1932 x 1932 pixels — 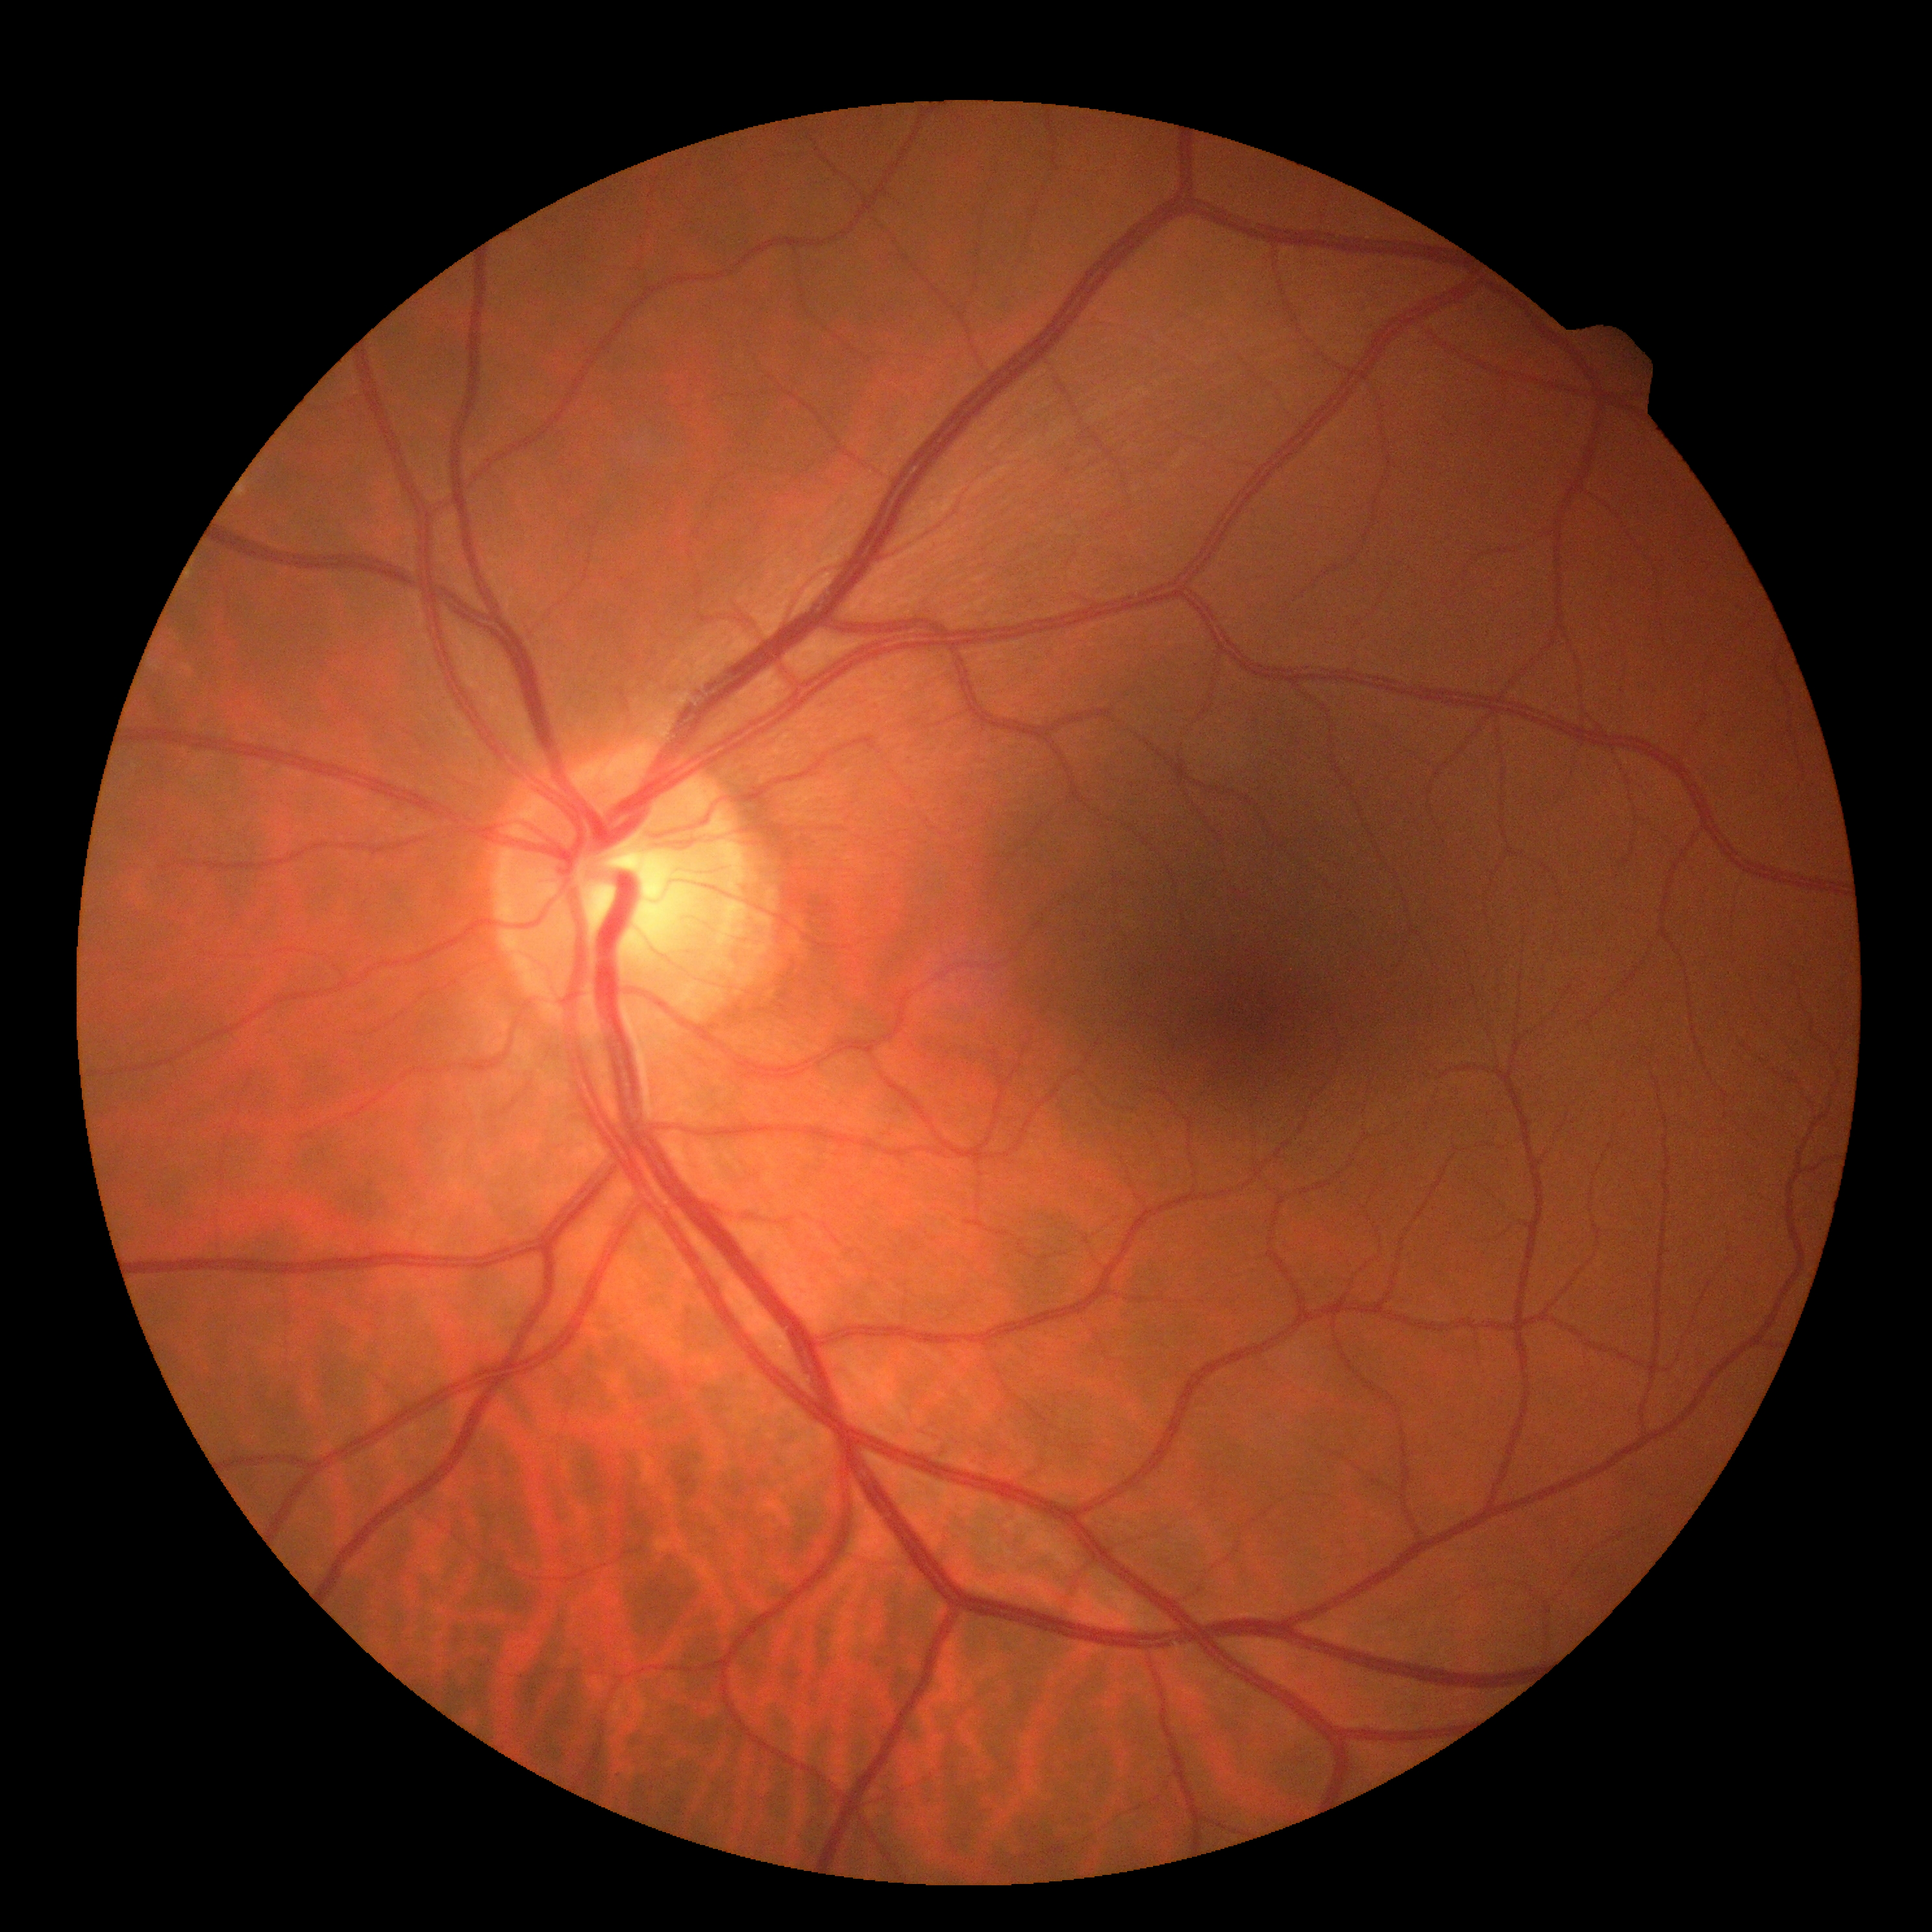 DR: grade 0 (no apparent retinopathy).